Camera: Nidek AFC-330 — 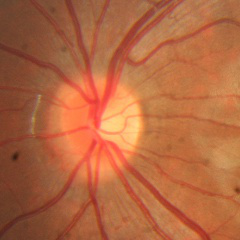 No glaucoma.